1924x1556; 200-degree field of view — 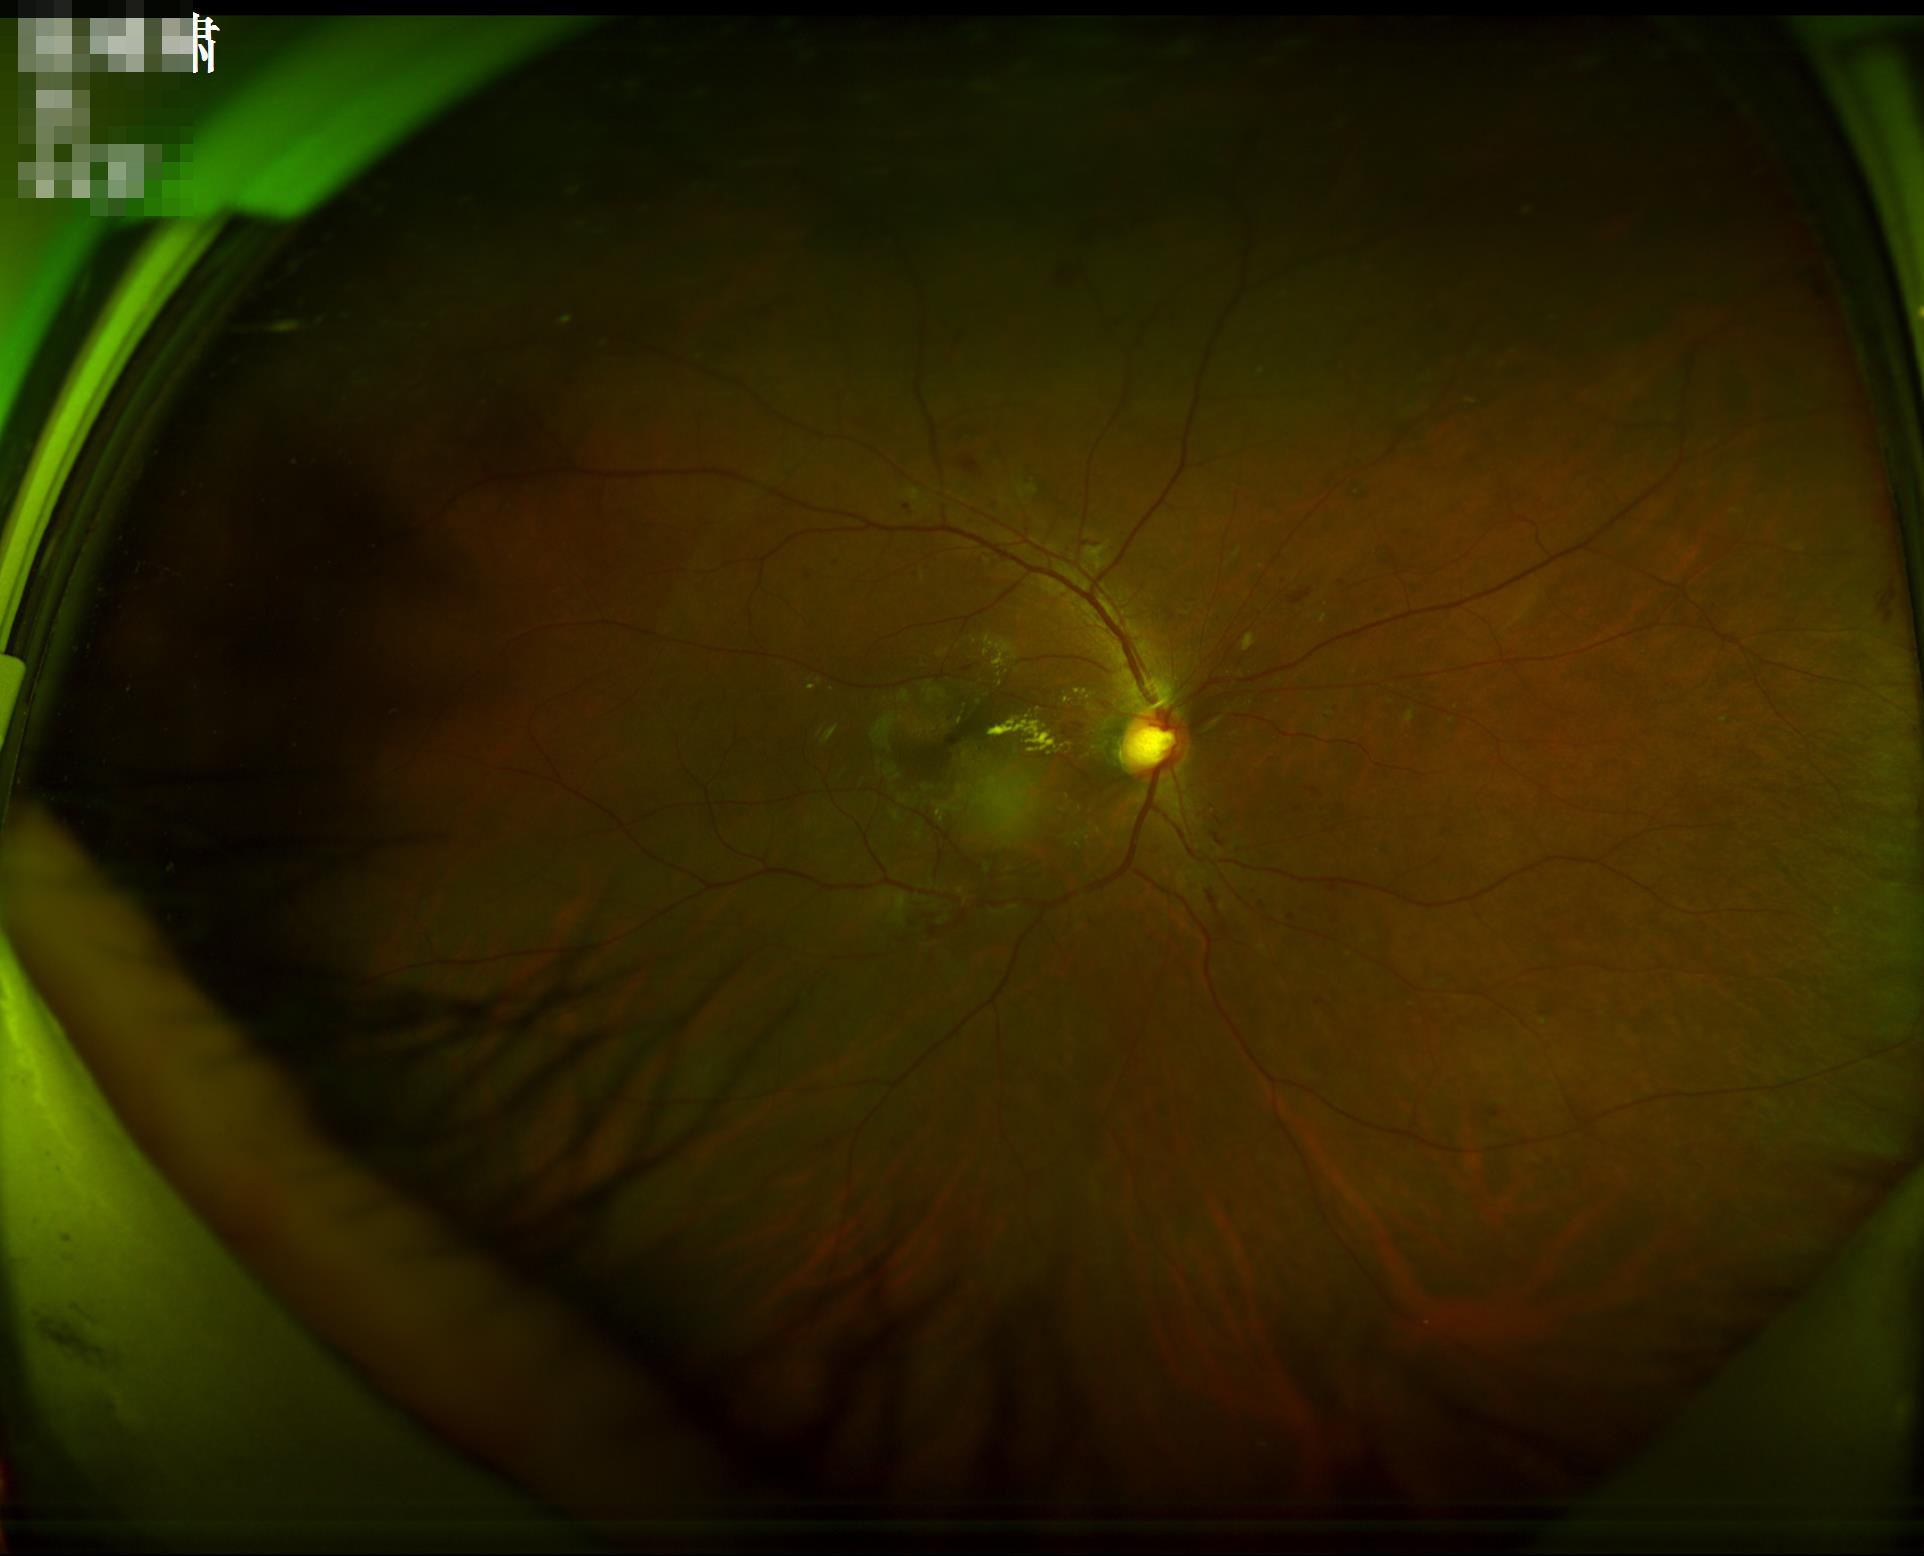

Image quality: illumination/color: over- or under-exposed | clarity: optic disc, vessels, and background in focus | contrast: wide intensity range, structures distinguishable.